Image size 640x480. Pediatric wide-field fundus photograph. Camera: Clarity RetCam 3 (130° FOV): 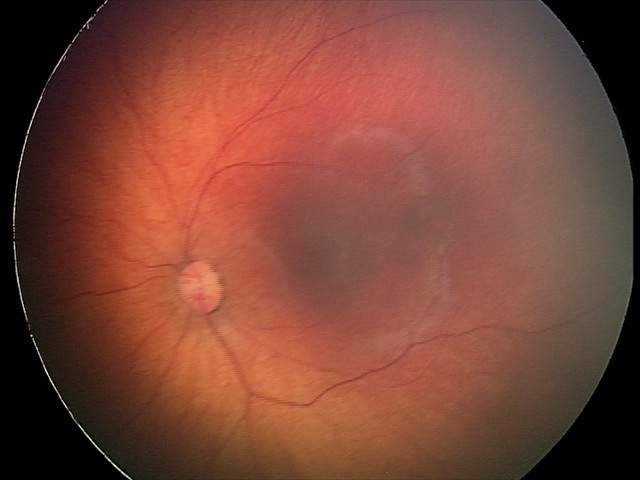

Impression: retinal hemorrhages.